Nonmydriatic. 45° field of view. 848x848px — 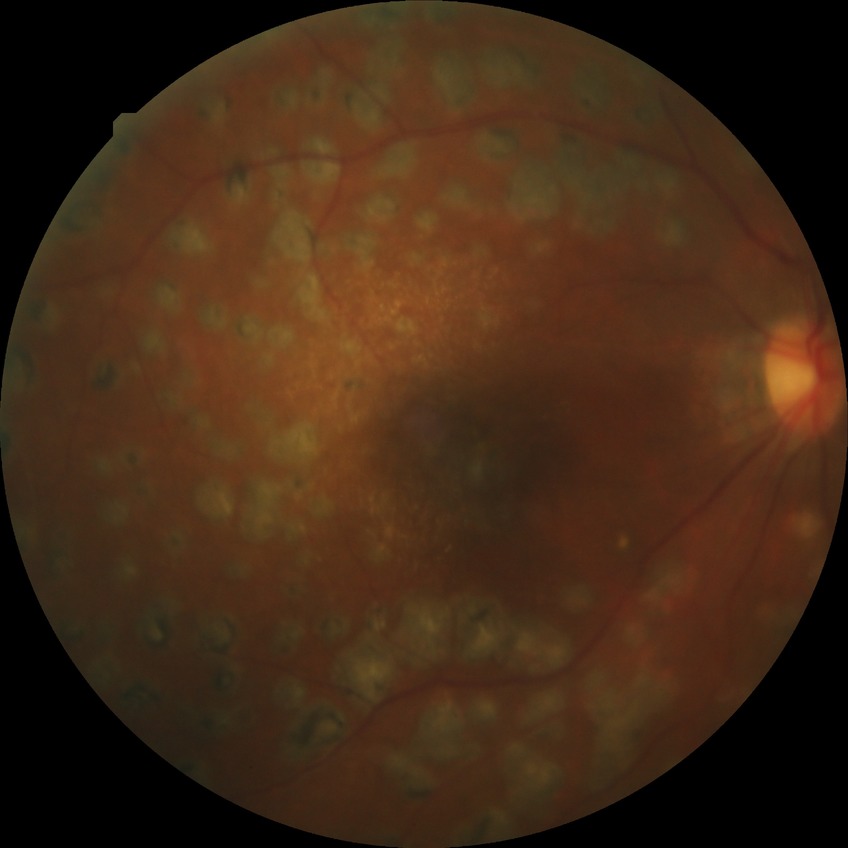 DR severity: PDR.